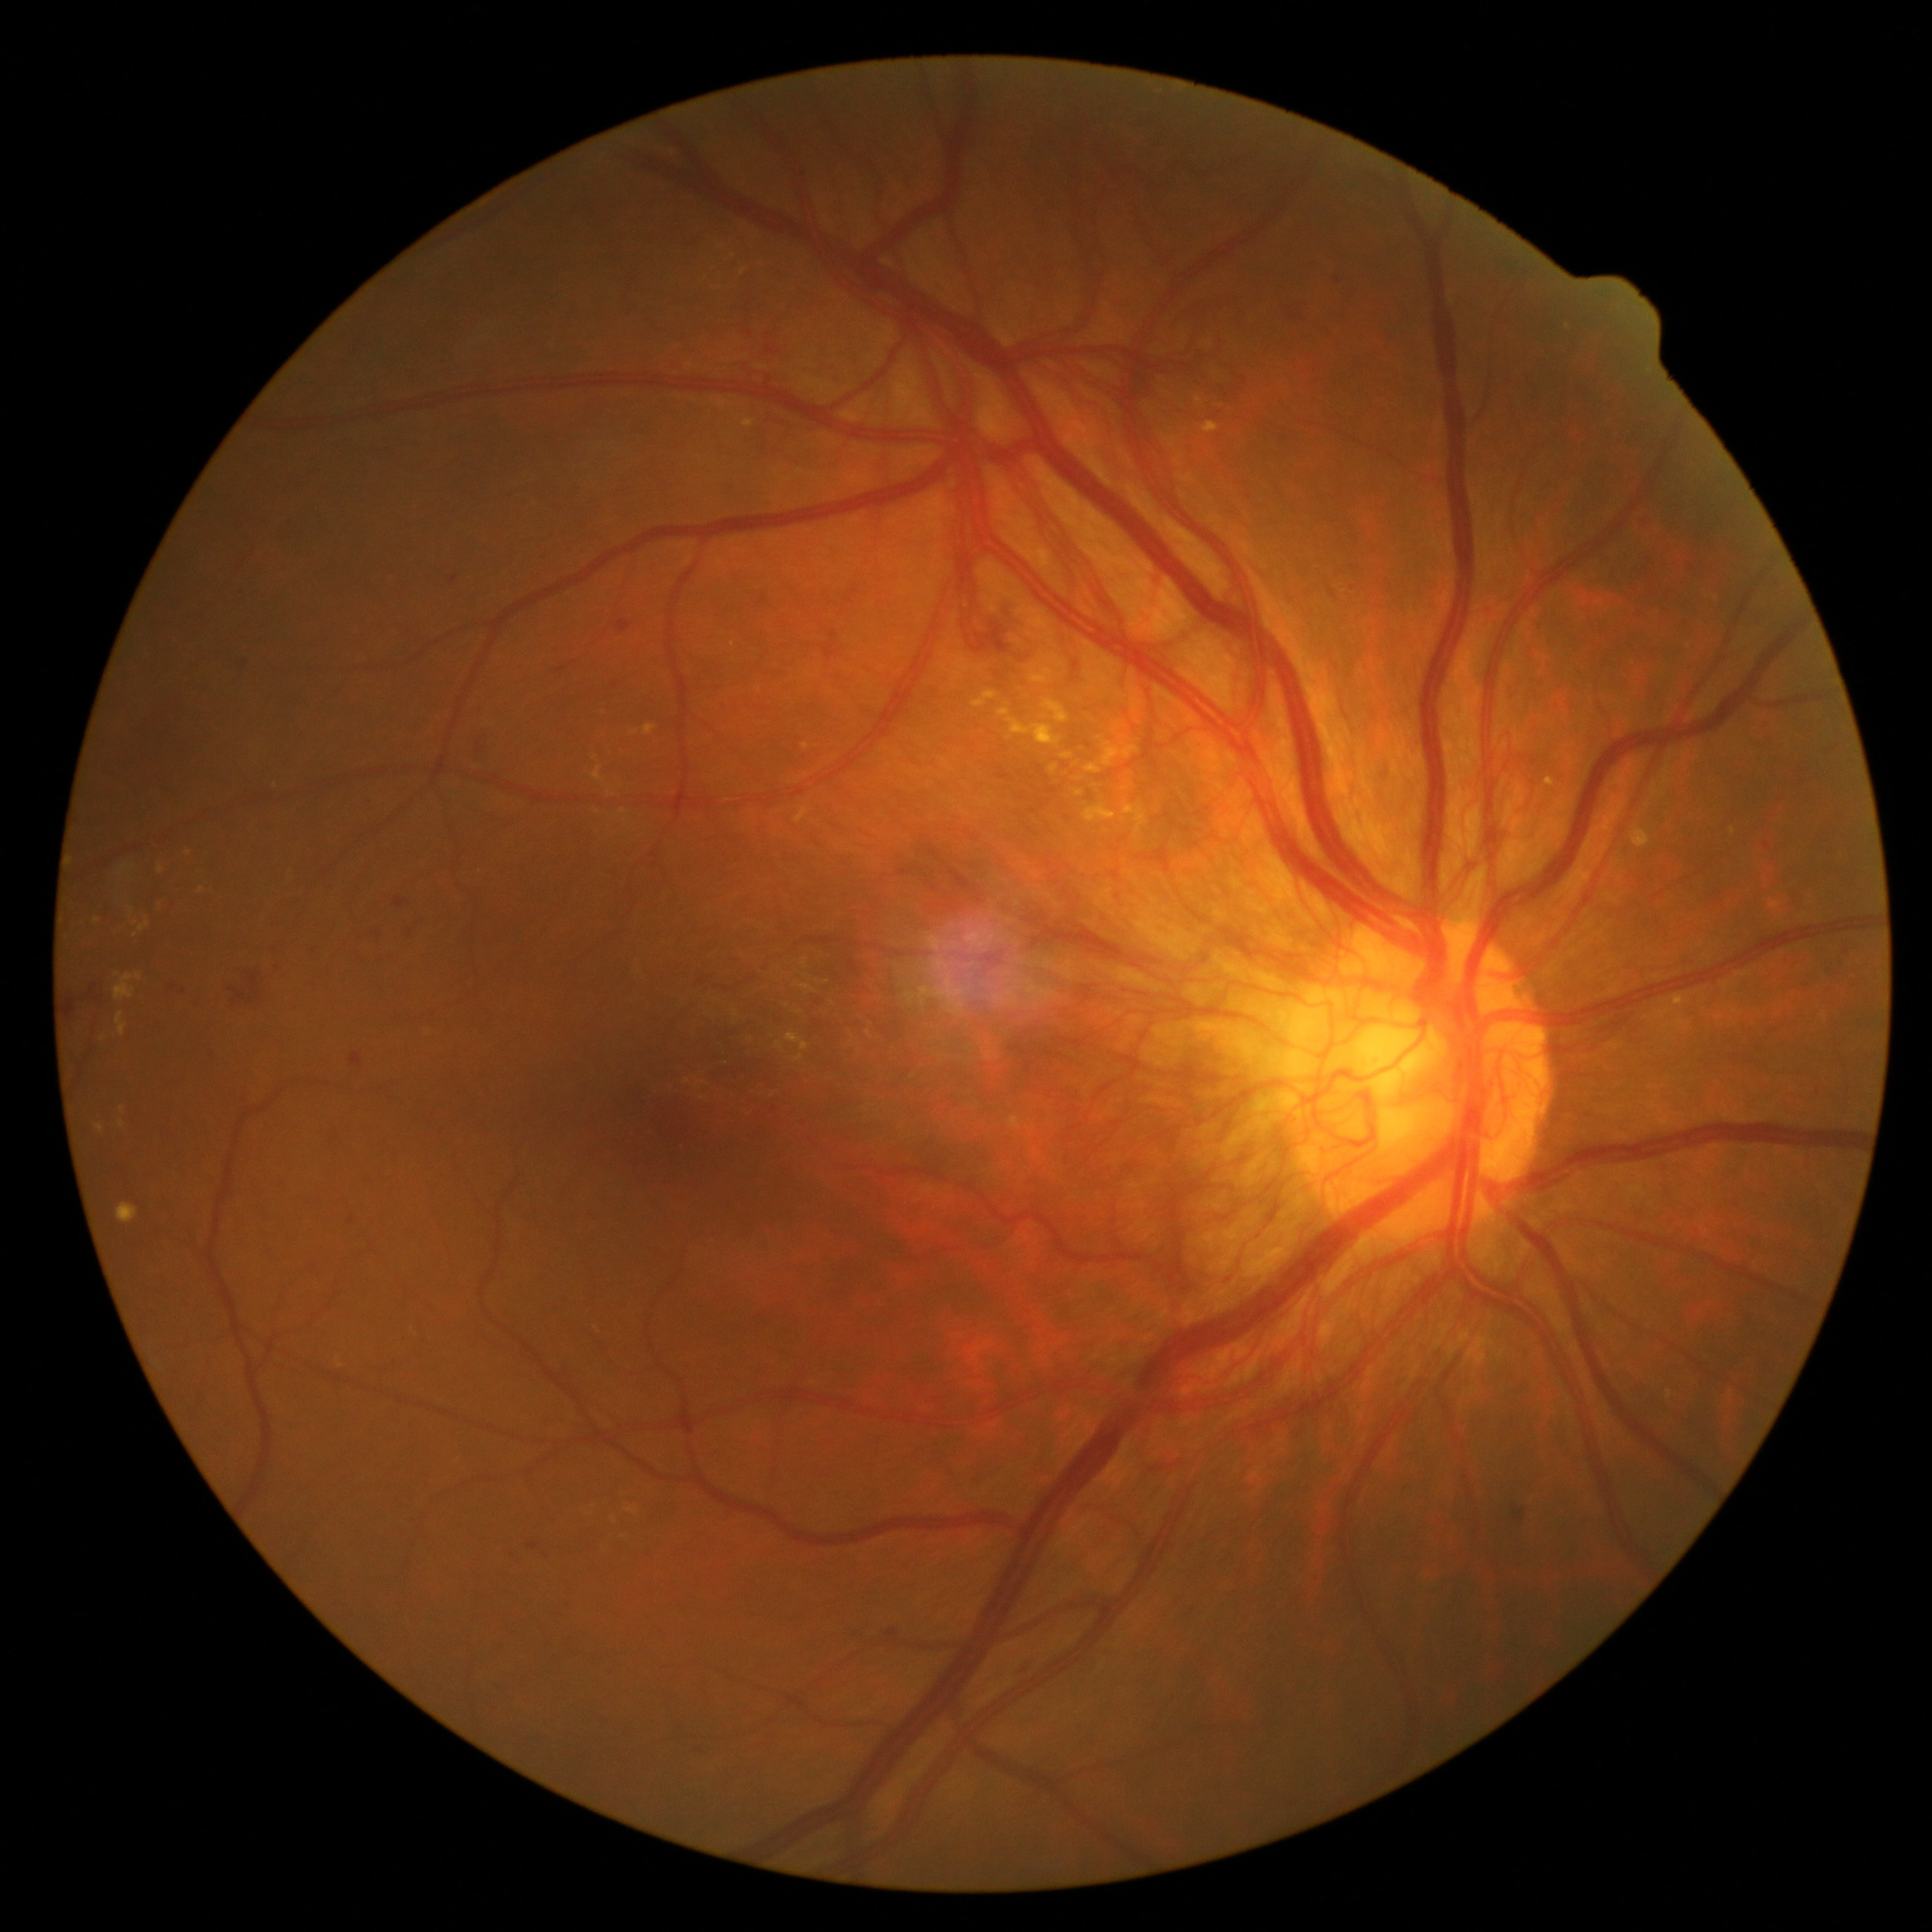 <lesions partial="true">
  <dr_grade>4</dr_grade>
  <ex partial="true">[1050,765,1059,774] | [113,974,135,1000] | [1075,792,1084,797] | [744,419,755,428] | [1123,804,1149,838] | [1084,765,1102,774] | [1028,668,1054,684] | [158,866,164,875] | [592,765,605,783]</ex>
  <ex_small_centers>(429,1033) | (1125,790) | (597,758) | (132,913)</ex_small_centers>
</lesions>